848 x 848 pixels: 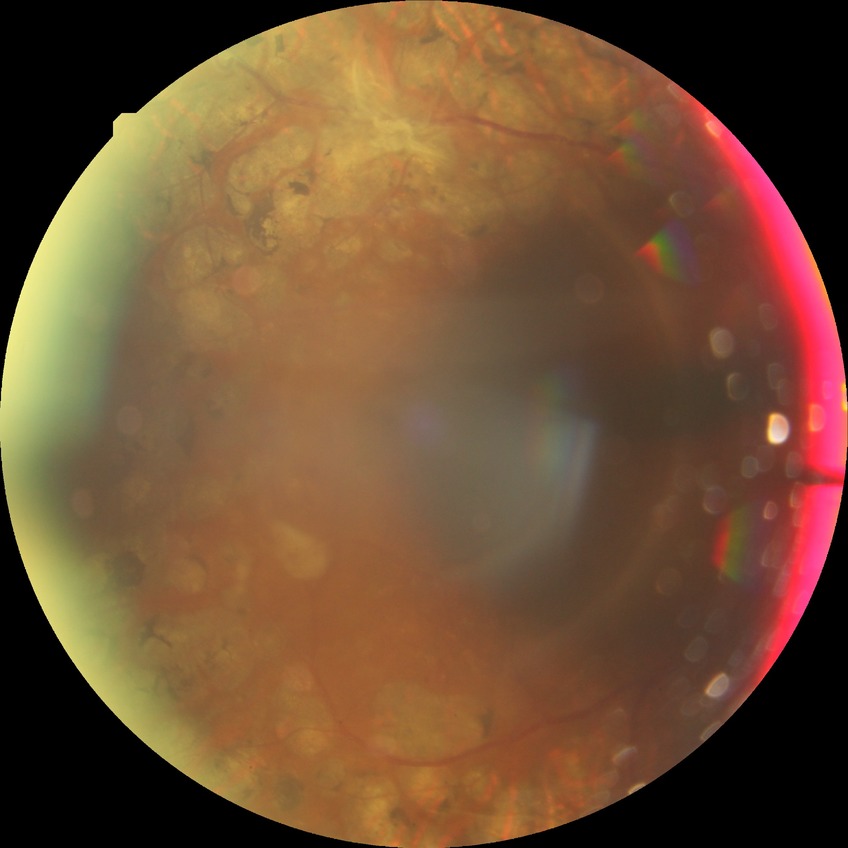
Diabetic retinopathy grade is proliferative diabetic retinopathy.